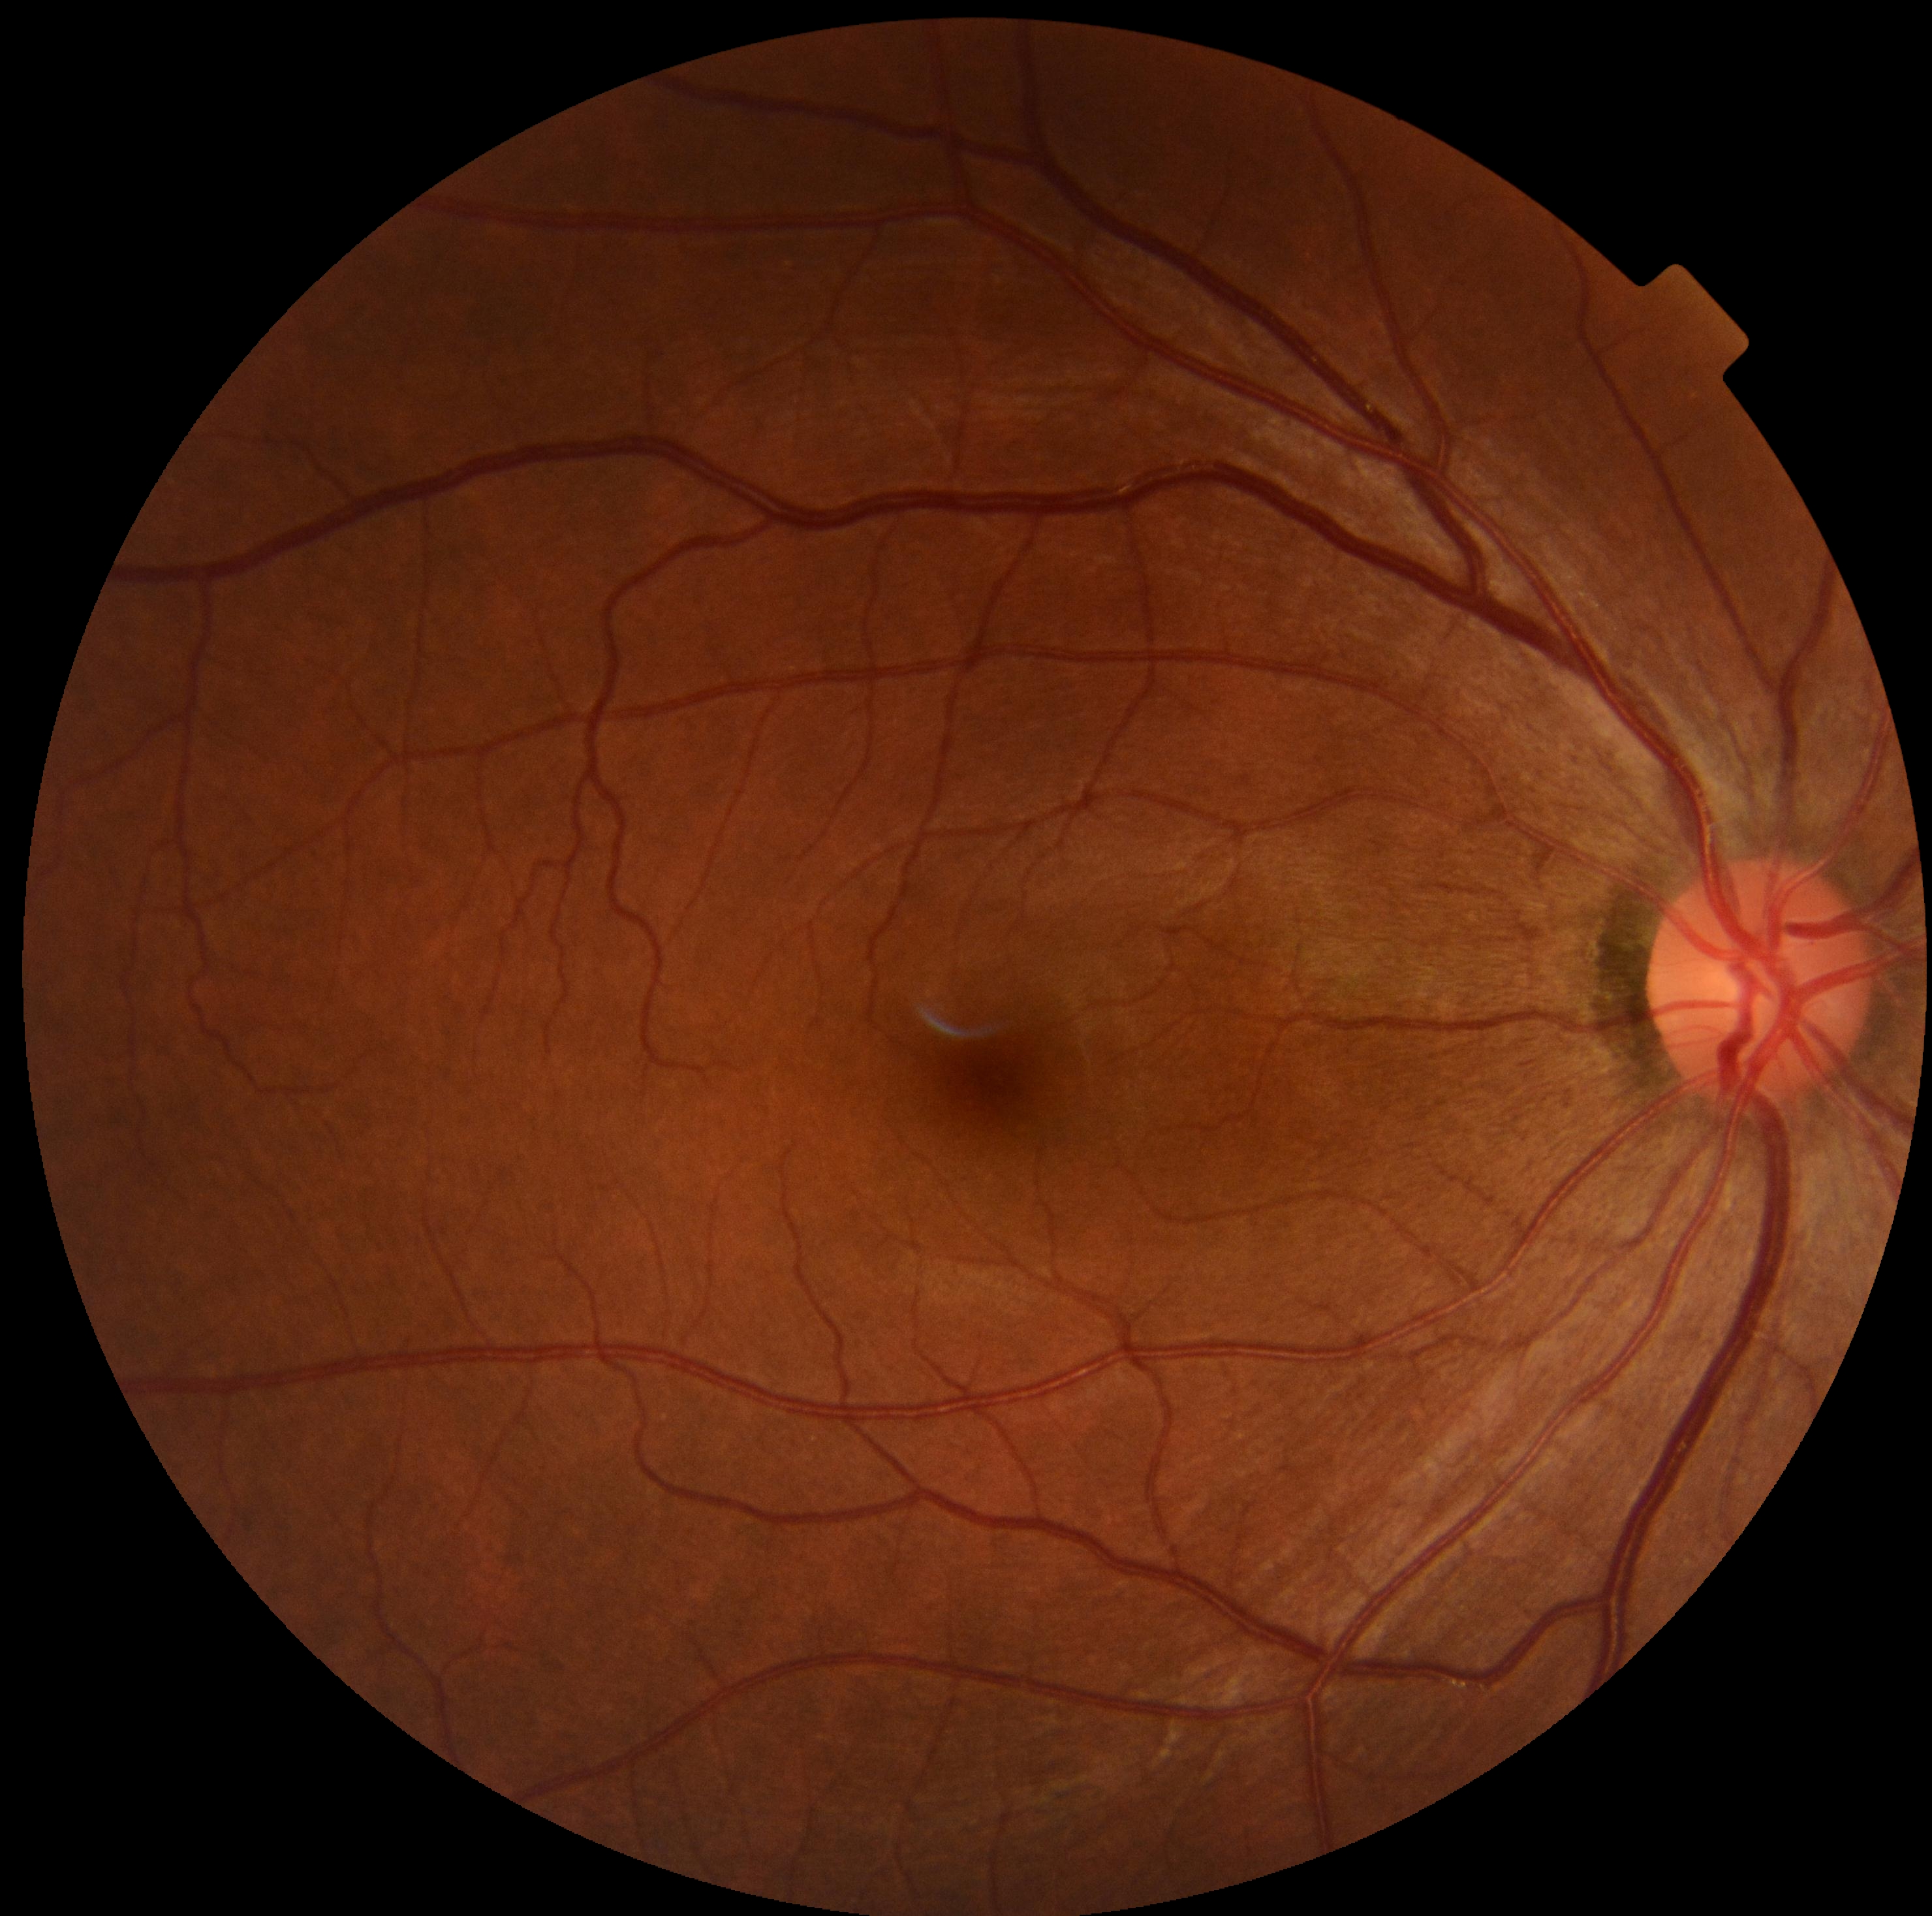

DR impression: negative for DR; DR stage: grade 0.